CFP. 45-degree field of view: 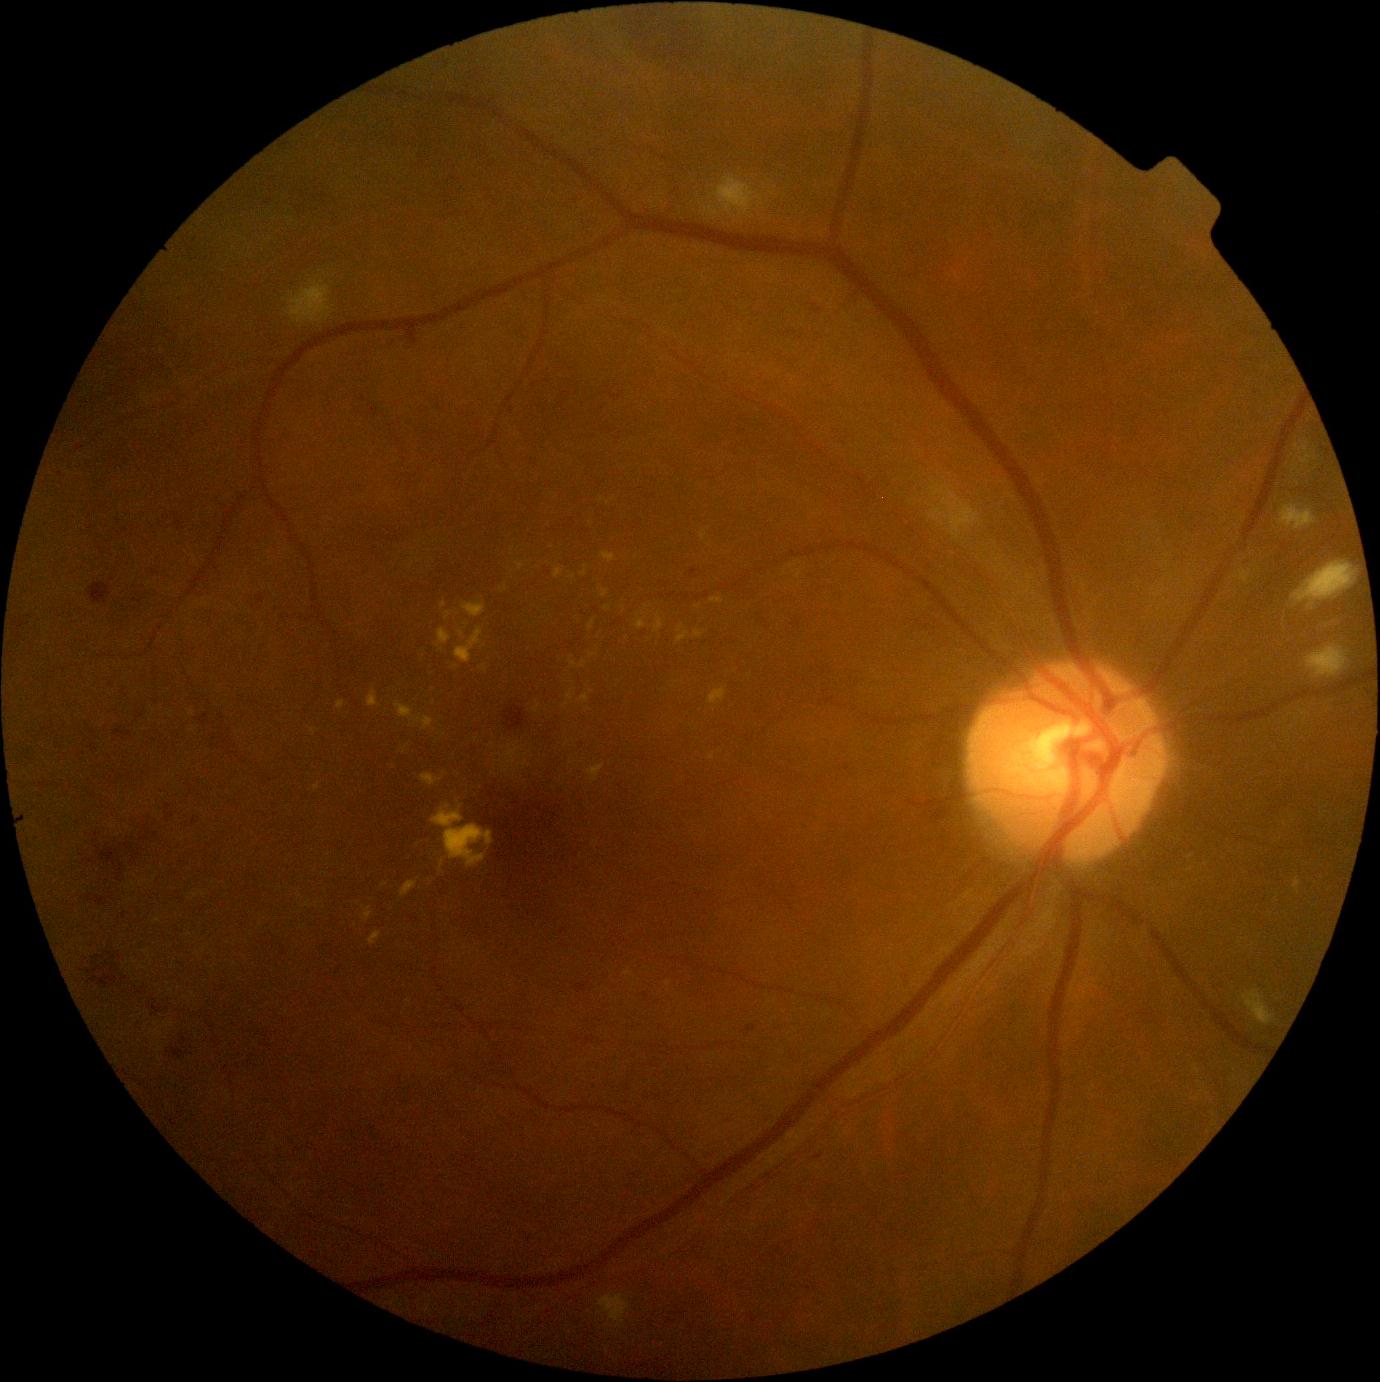
DR severity is grade 2 (moderate NPDR).